Modified Davis classification.
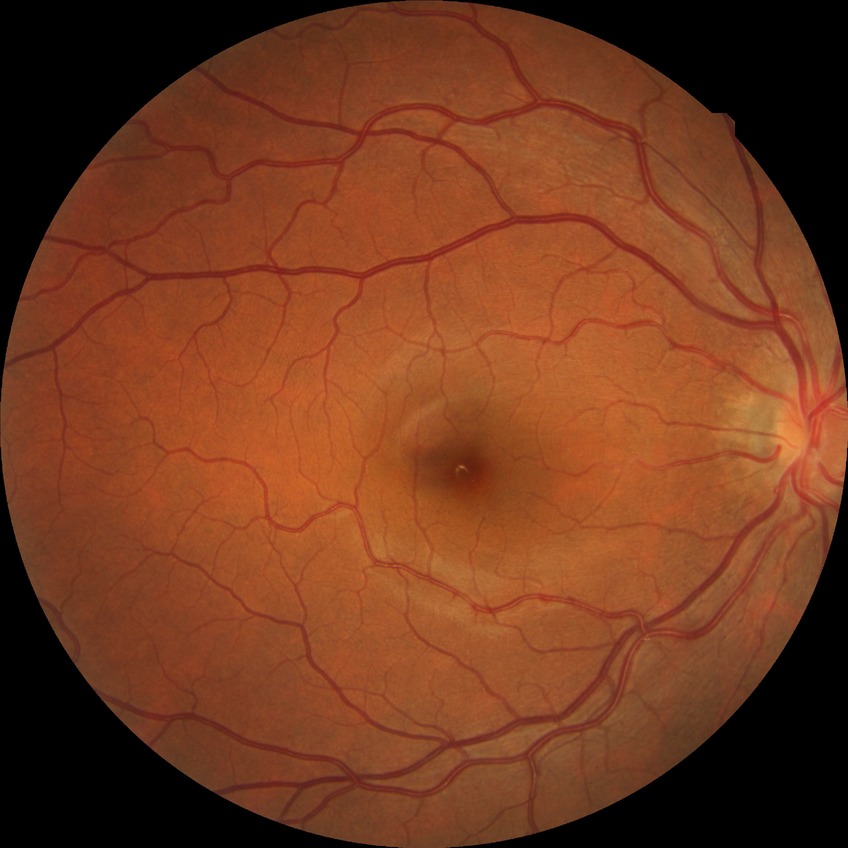
Diabetic retinopathy (DR) is no diabetic retinopathy (NDR).